45° FOV.
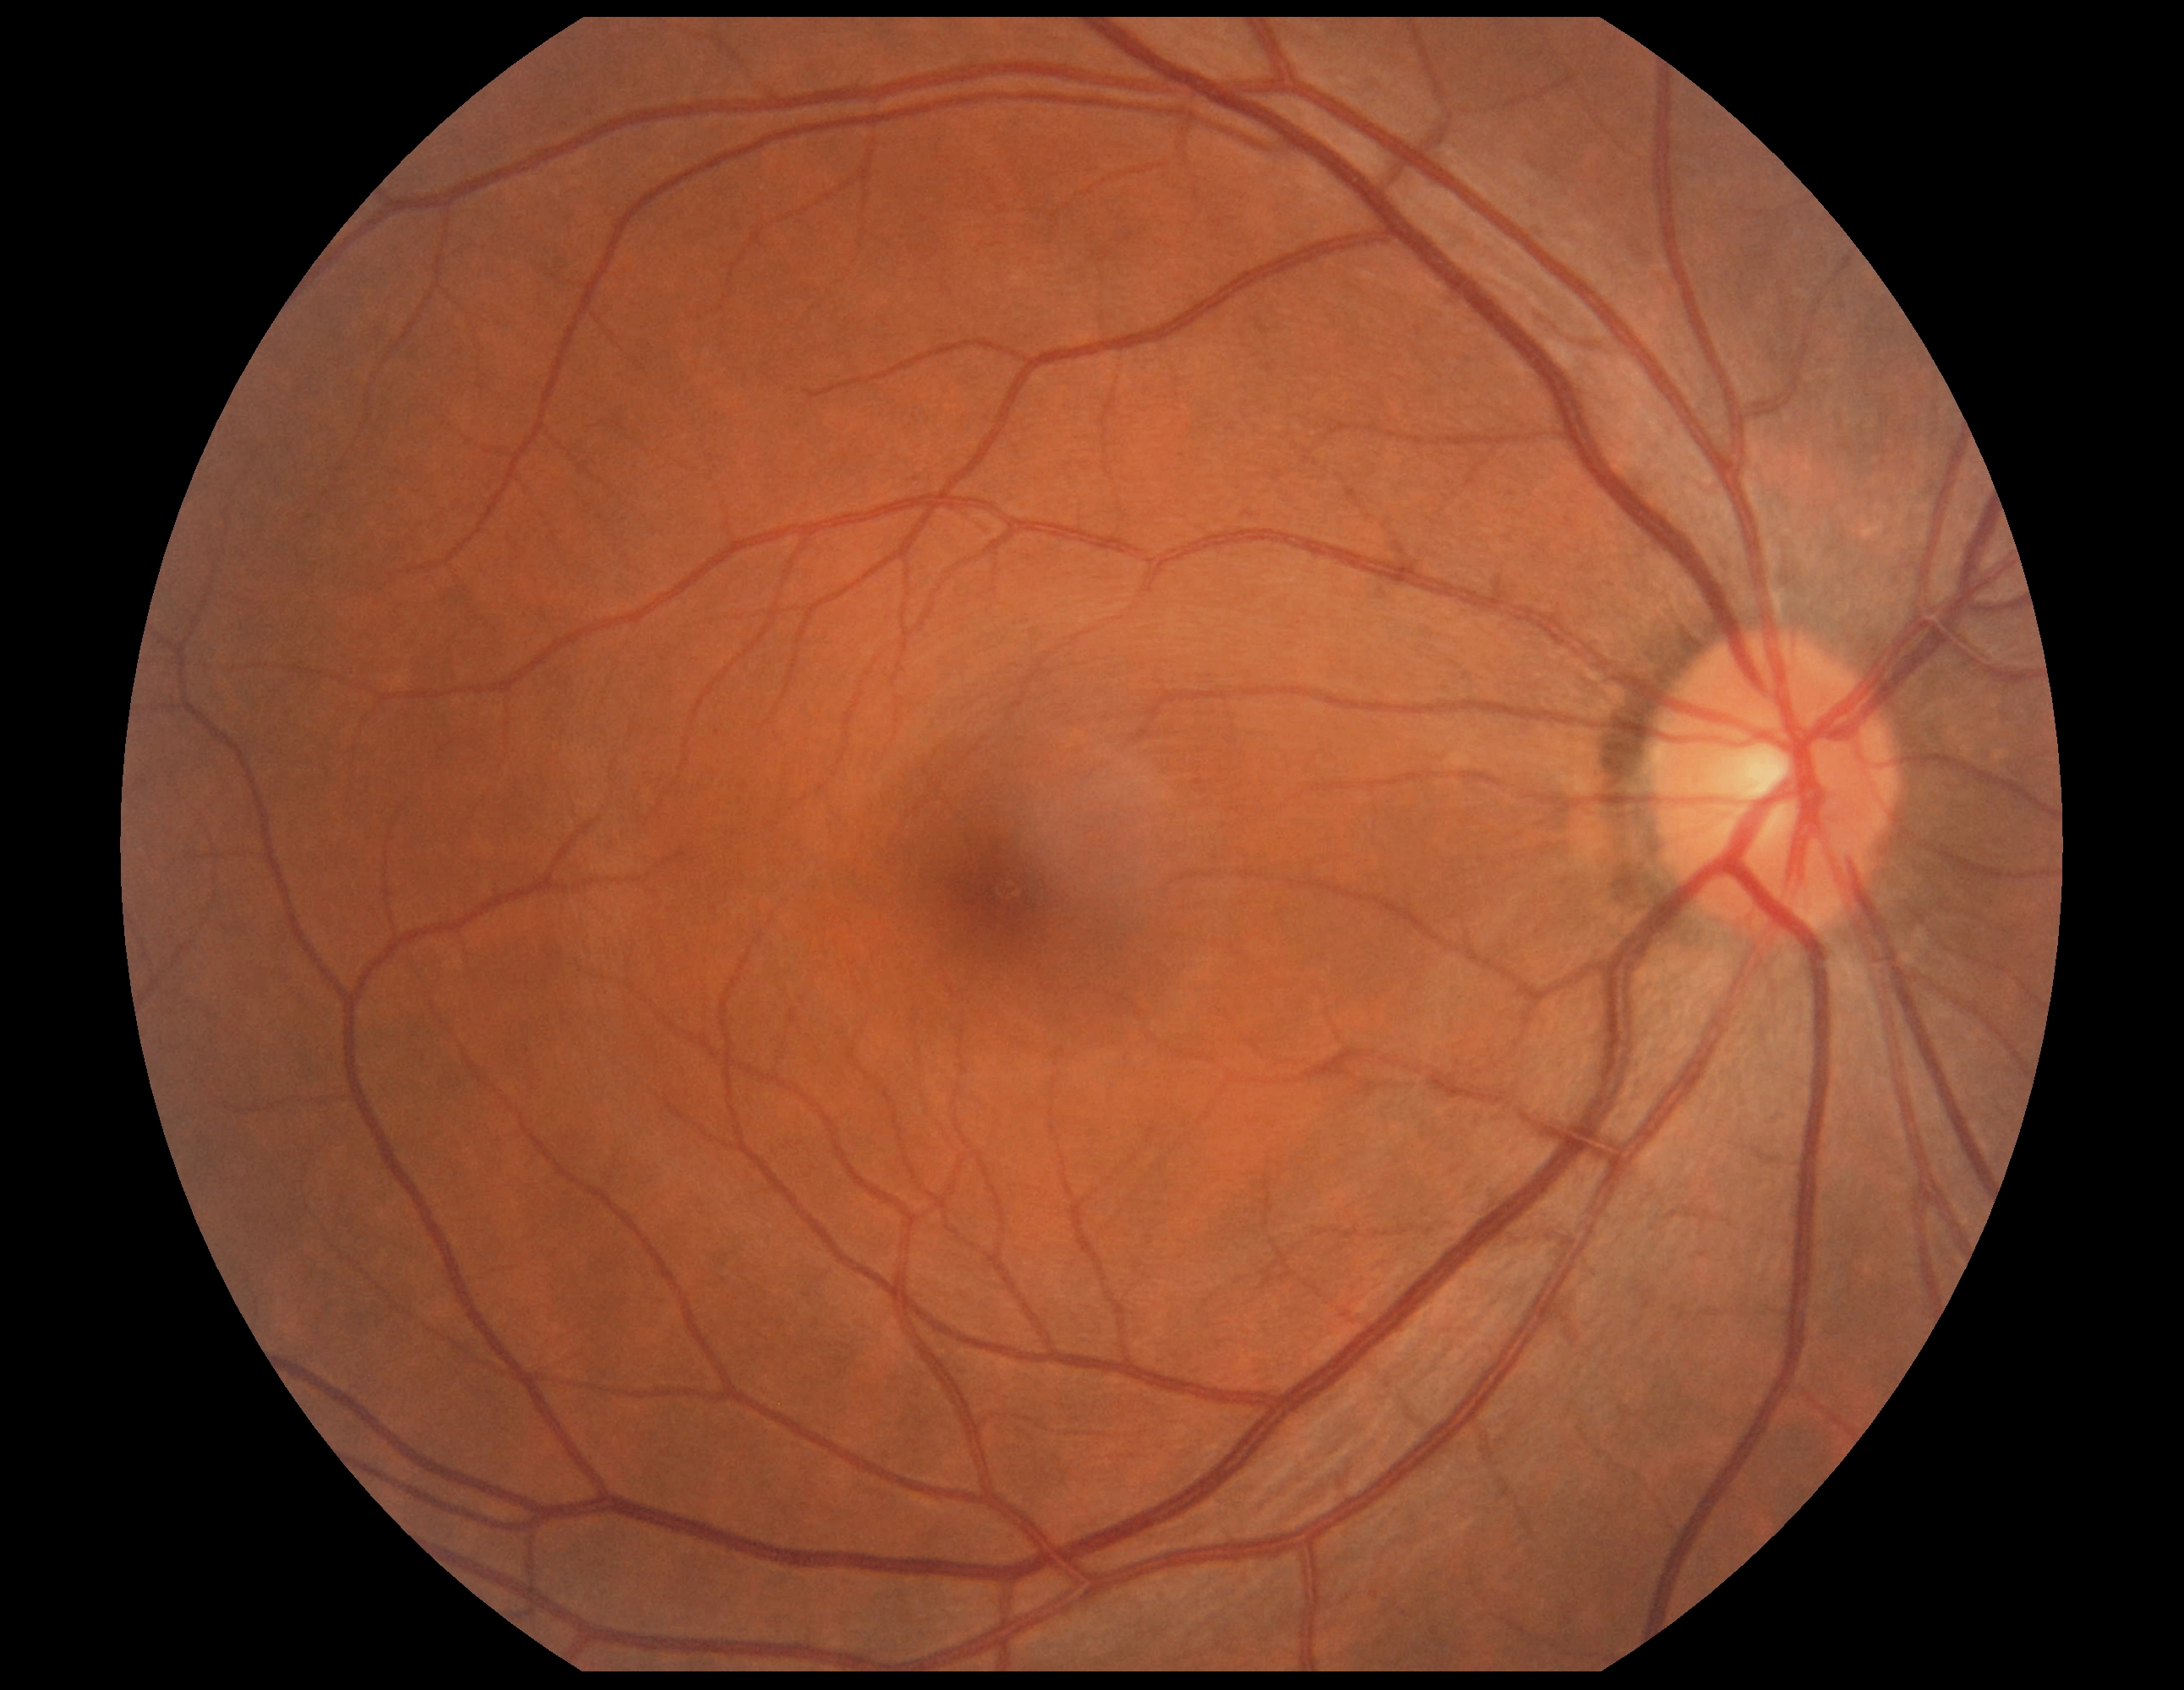

DR severity: no apparent diabetic retinopathy (grade 0).